CFP; 50-degree field of view.
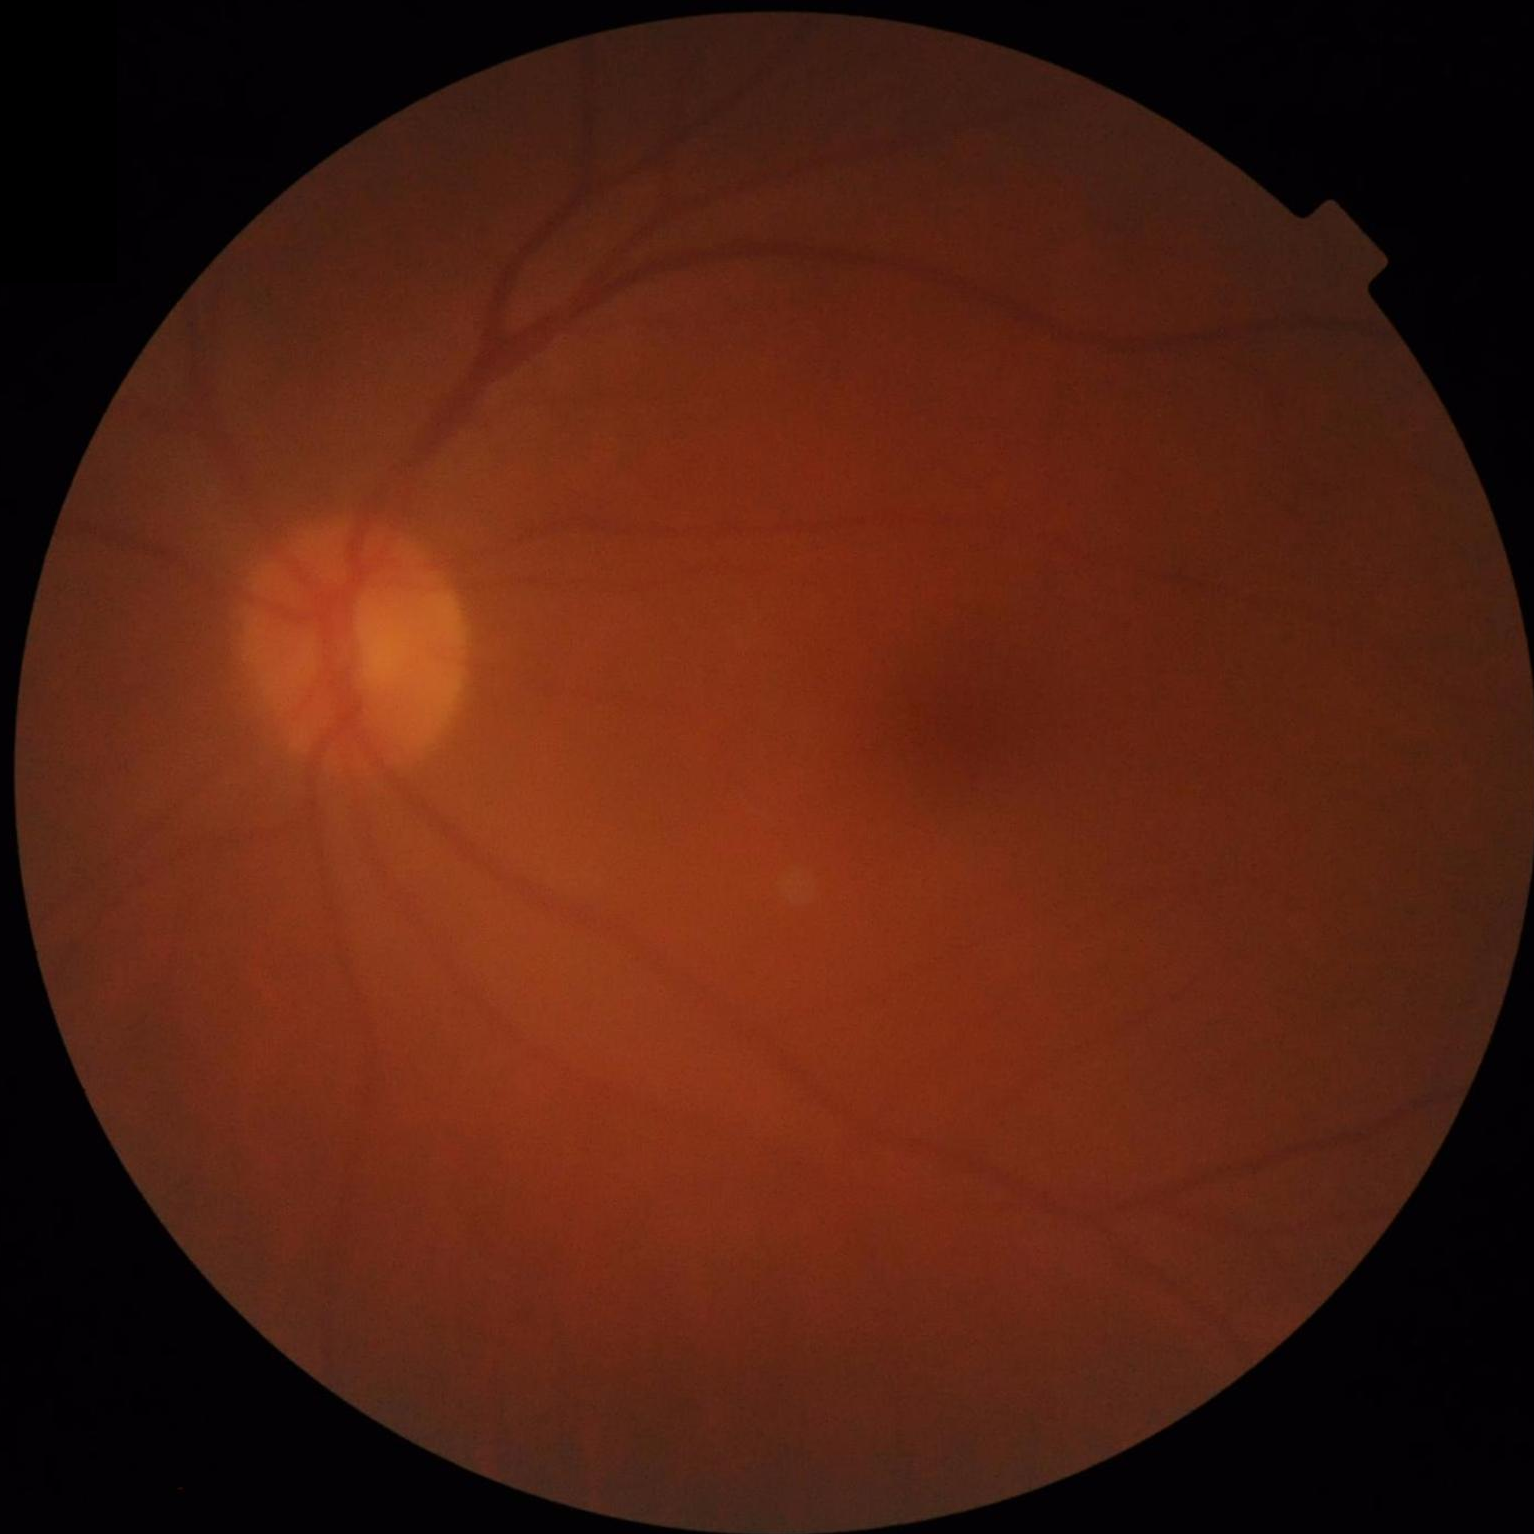

Good dynamic range. No over- or under-exposure. The image is blurry. Image quality is suboptimal.